Diabetic retinopathy graded by the modified Davis classification. Posterior pole color fundus photograph. 848 by 848 pixels: 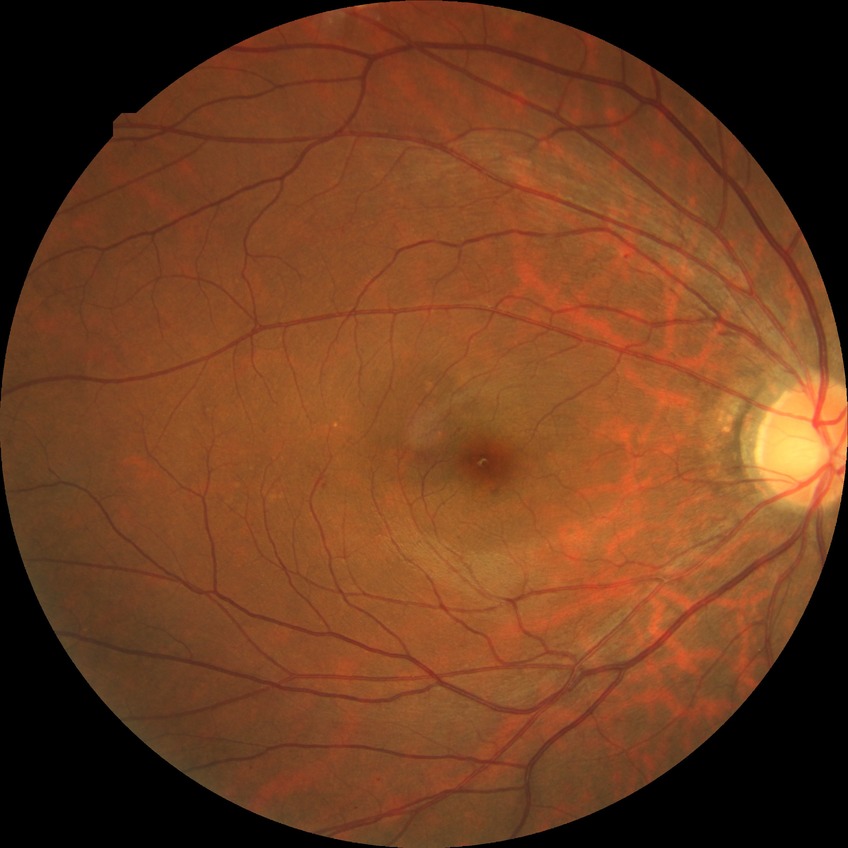 Diabetic retinopathy (DR): simple diabetic retinopathy (SDR).